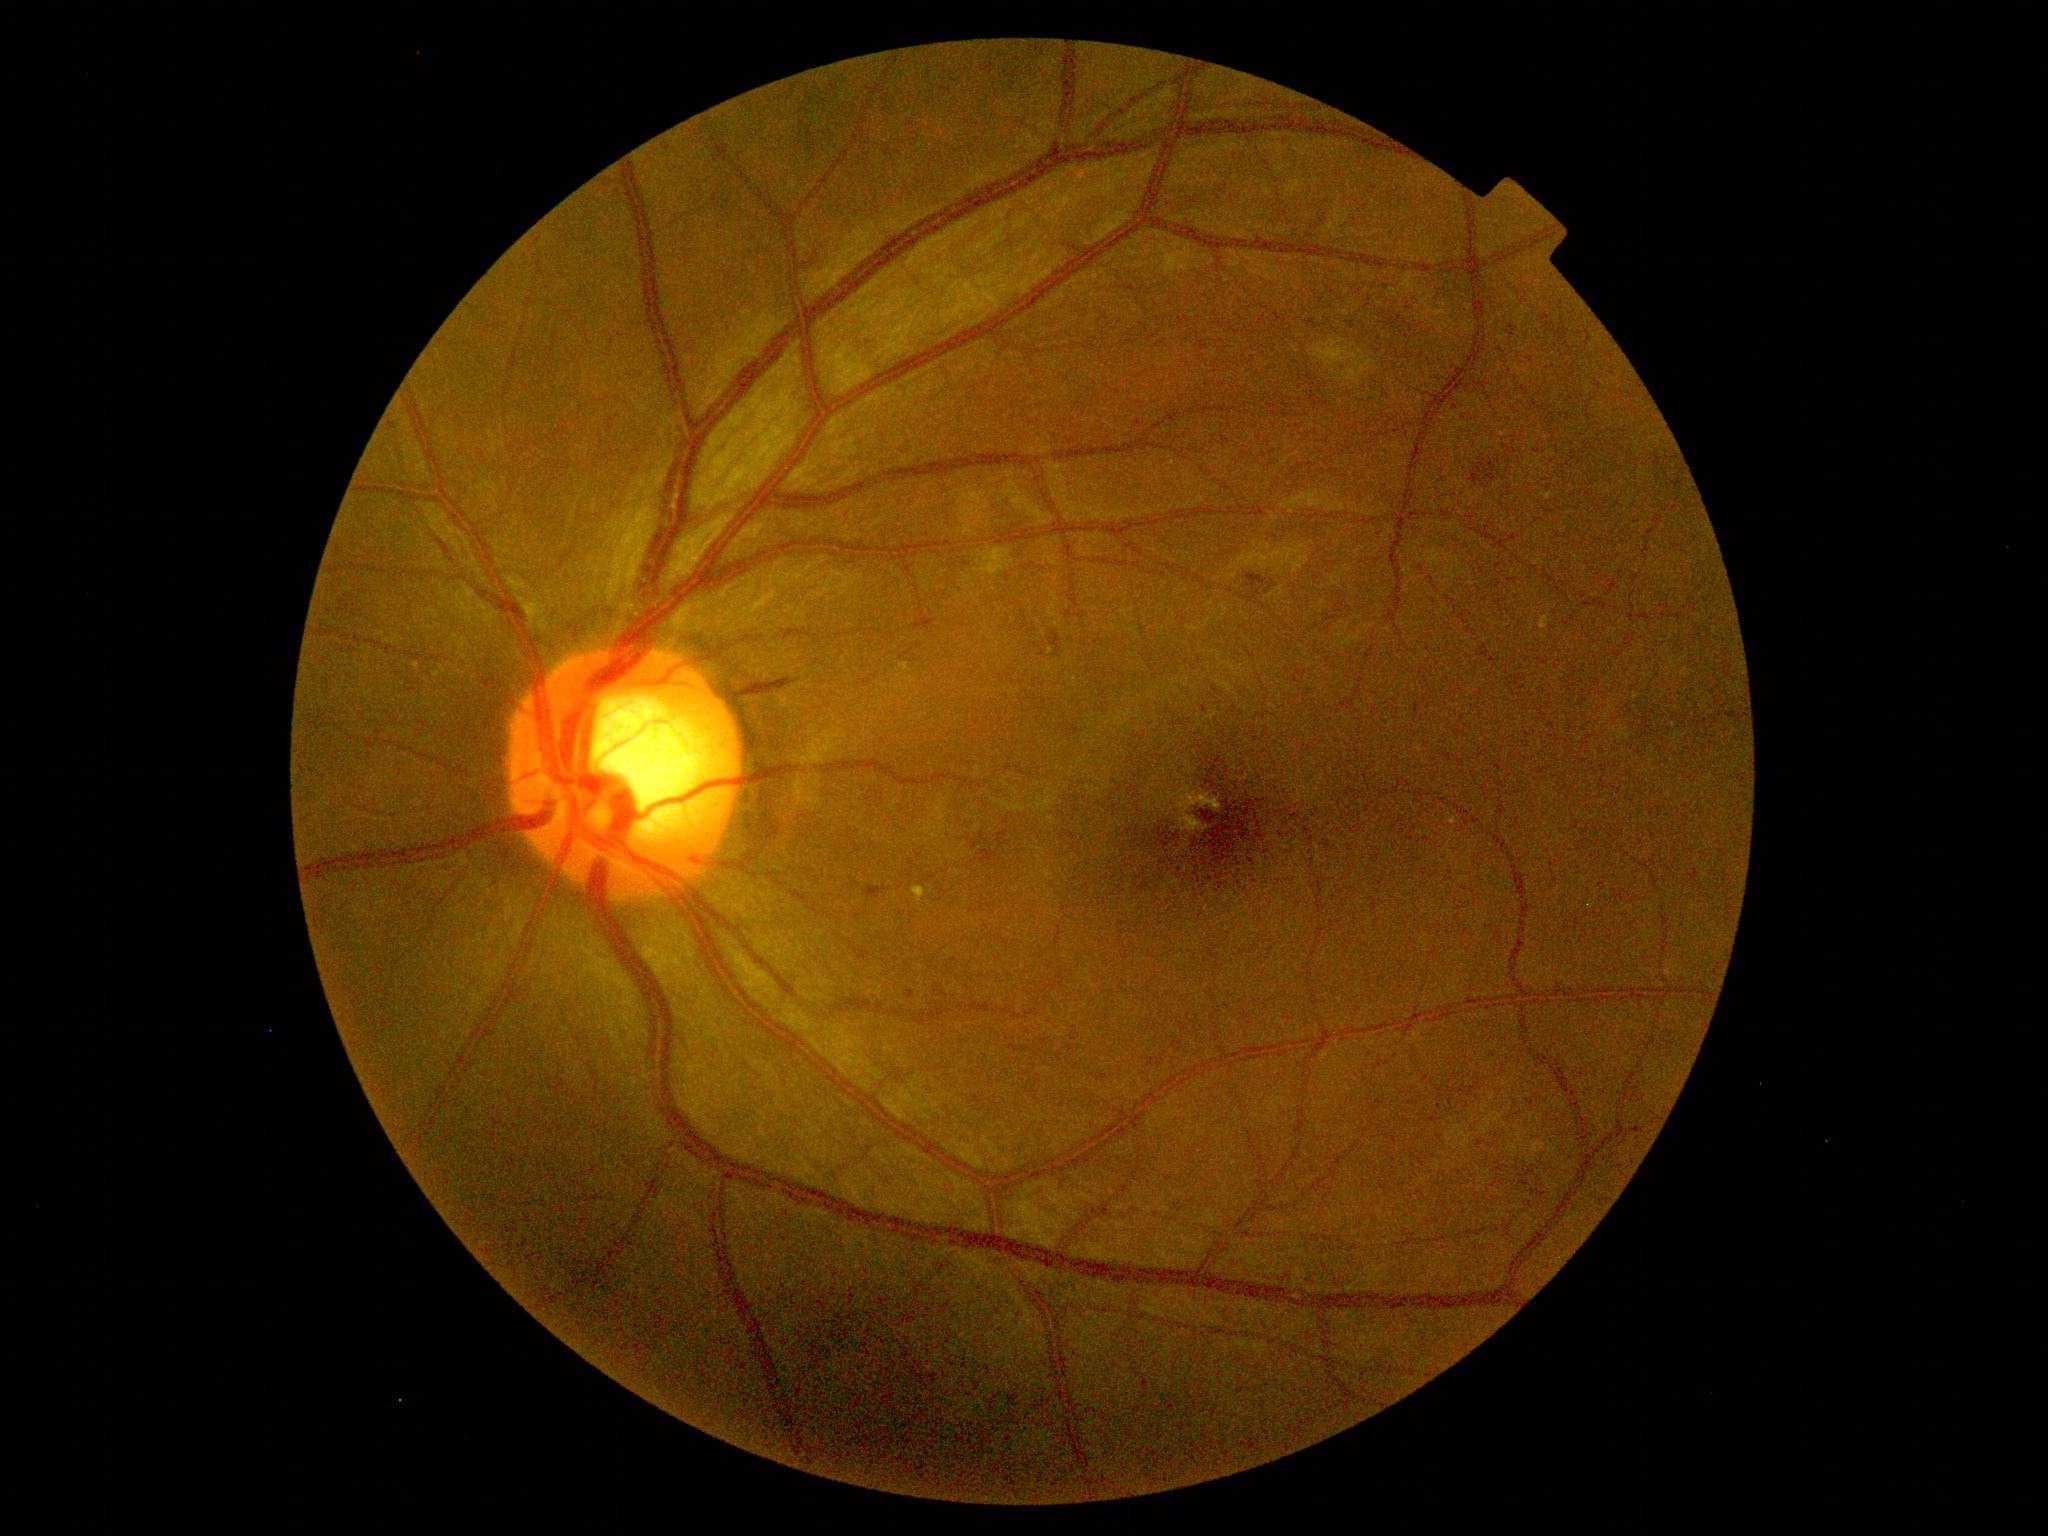

DR grade: 2 (moderate NPDR)